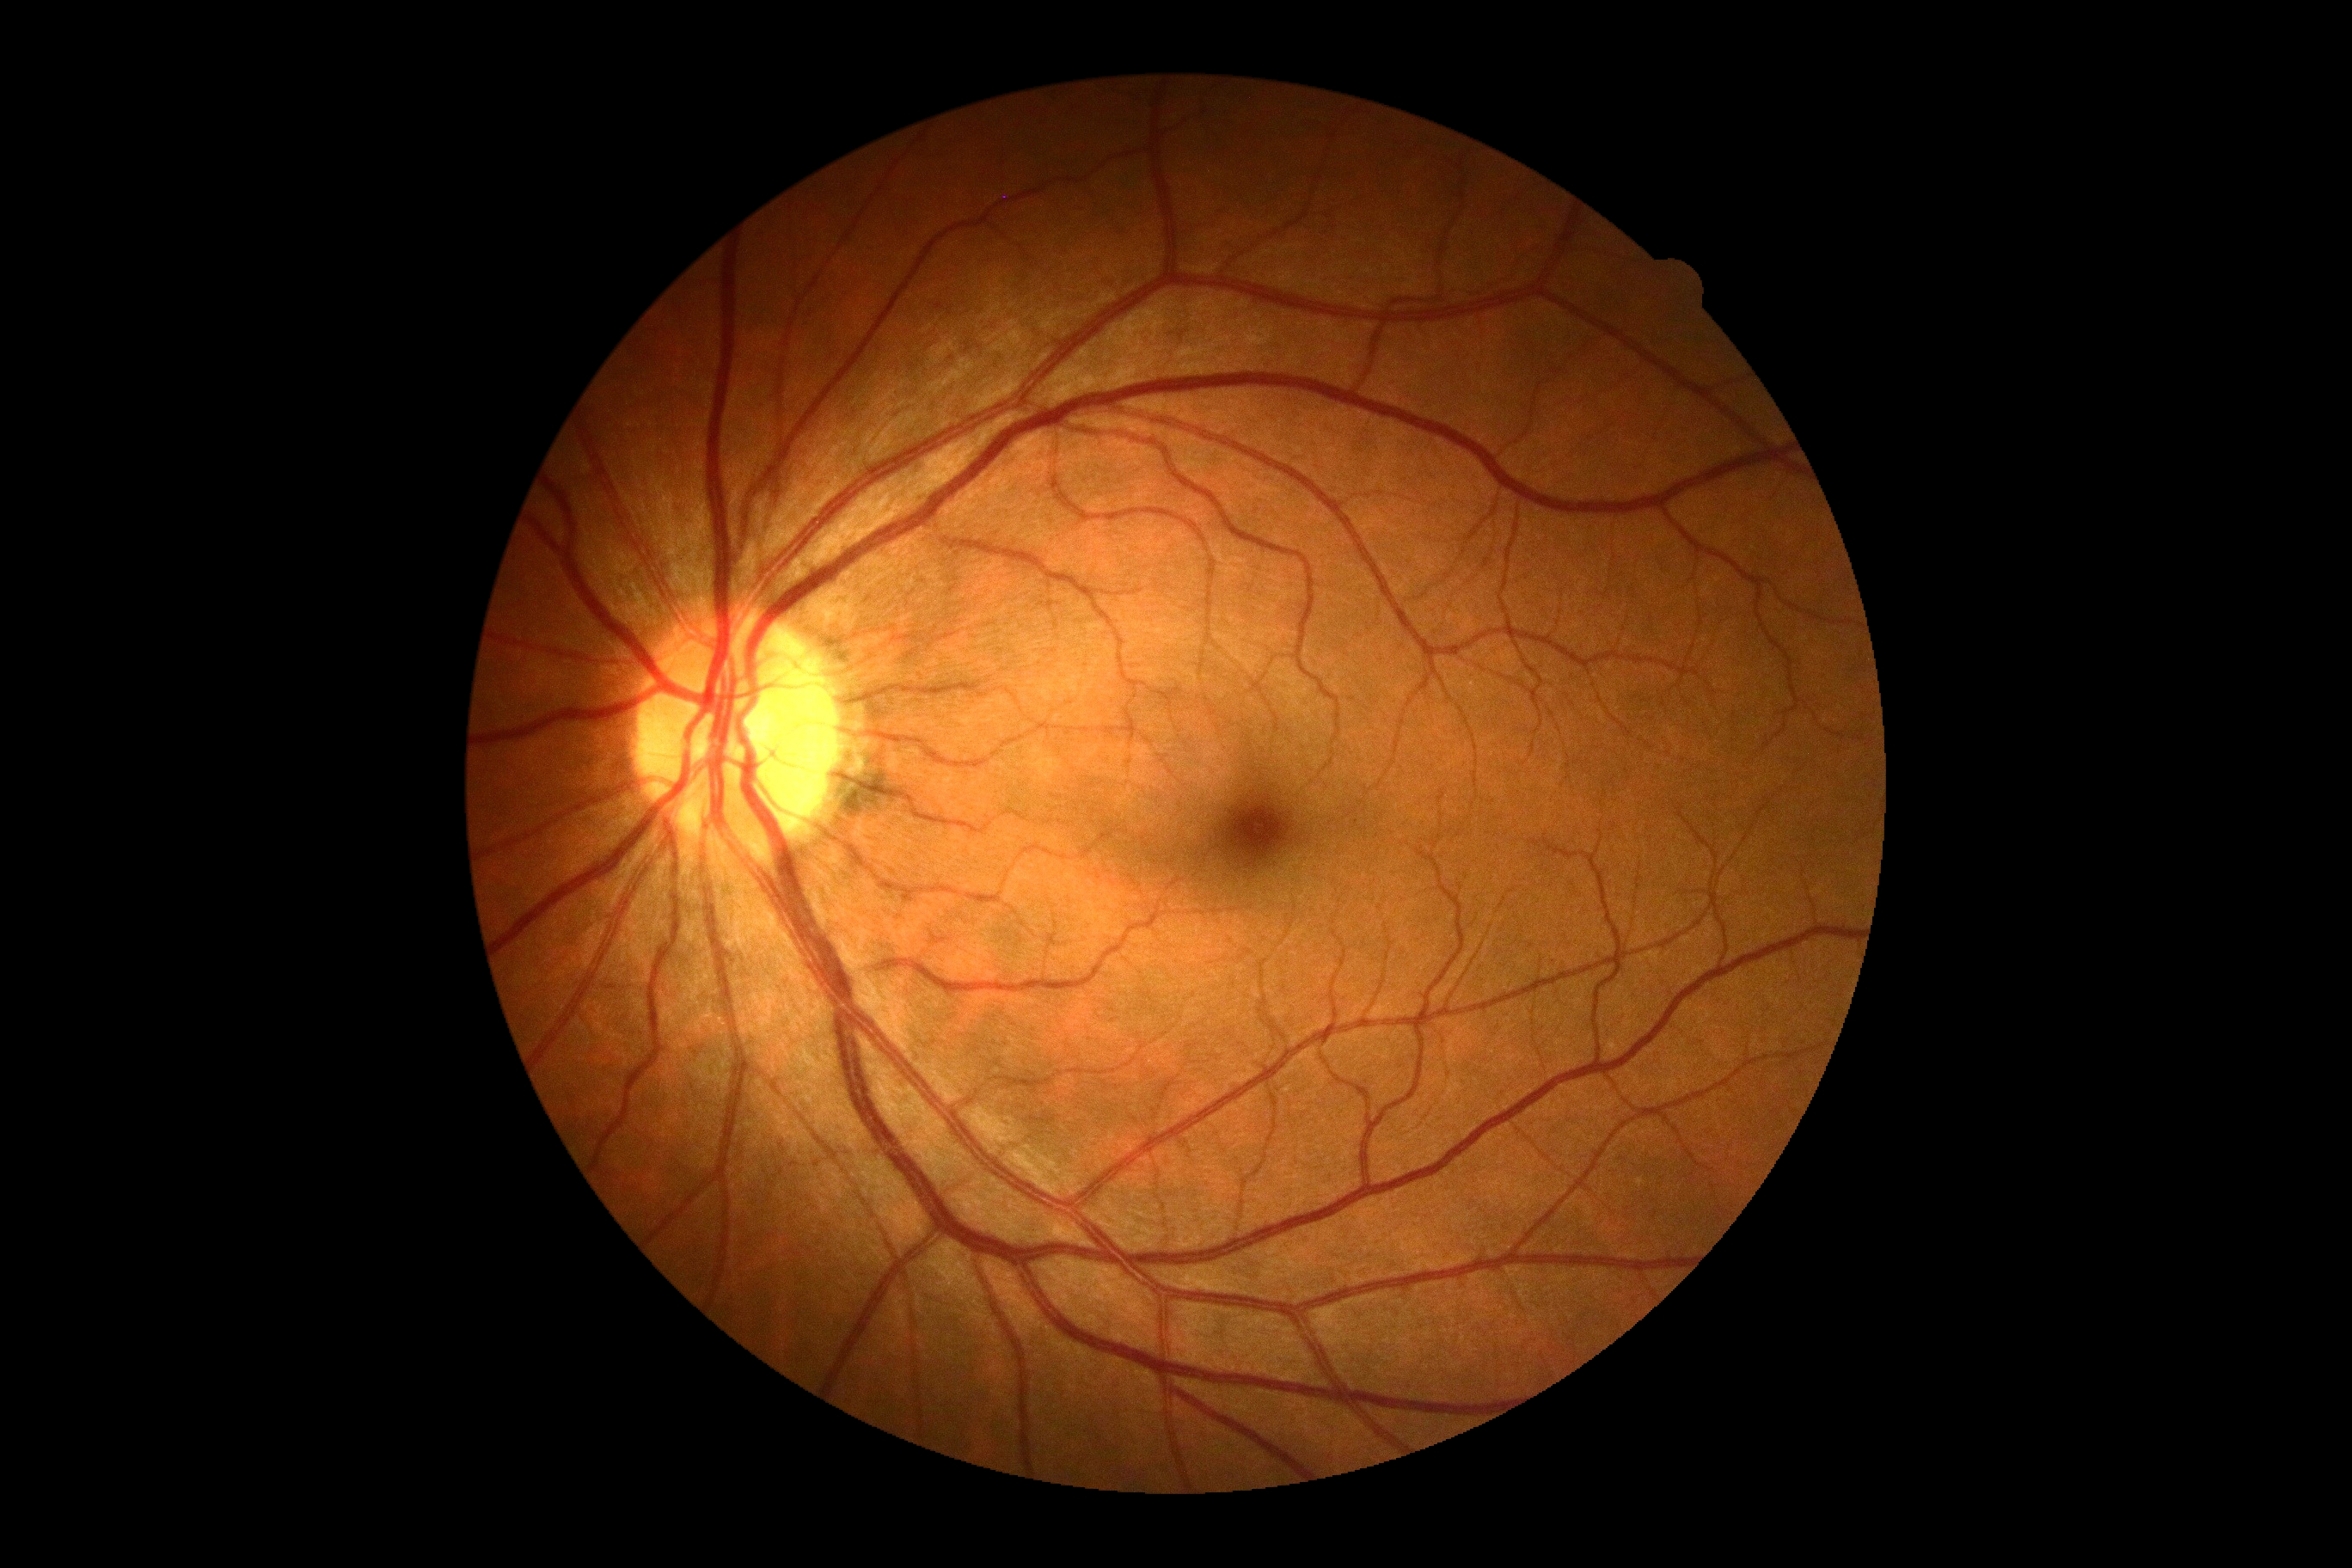
Diabetic retinopathy is grade 0 (no apparent retinopathy).